Acquired on the Phoenix ICON. Pediatric retinal photograph (wide-field).
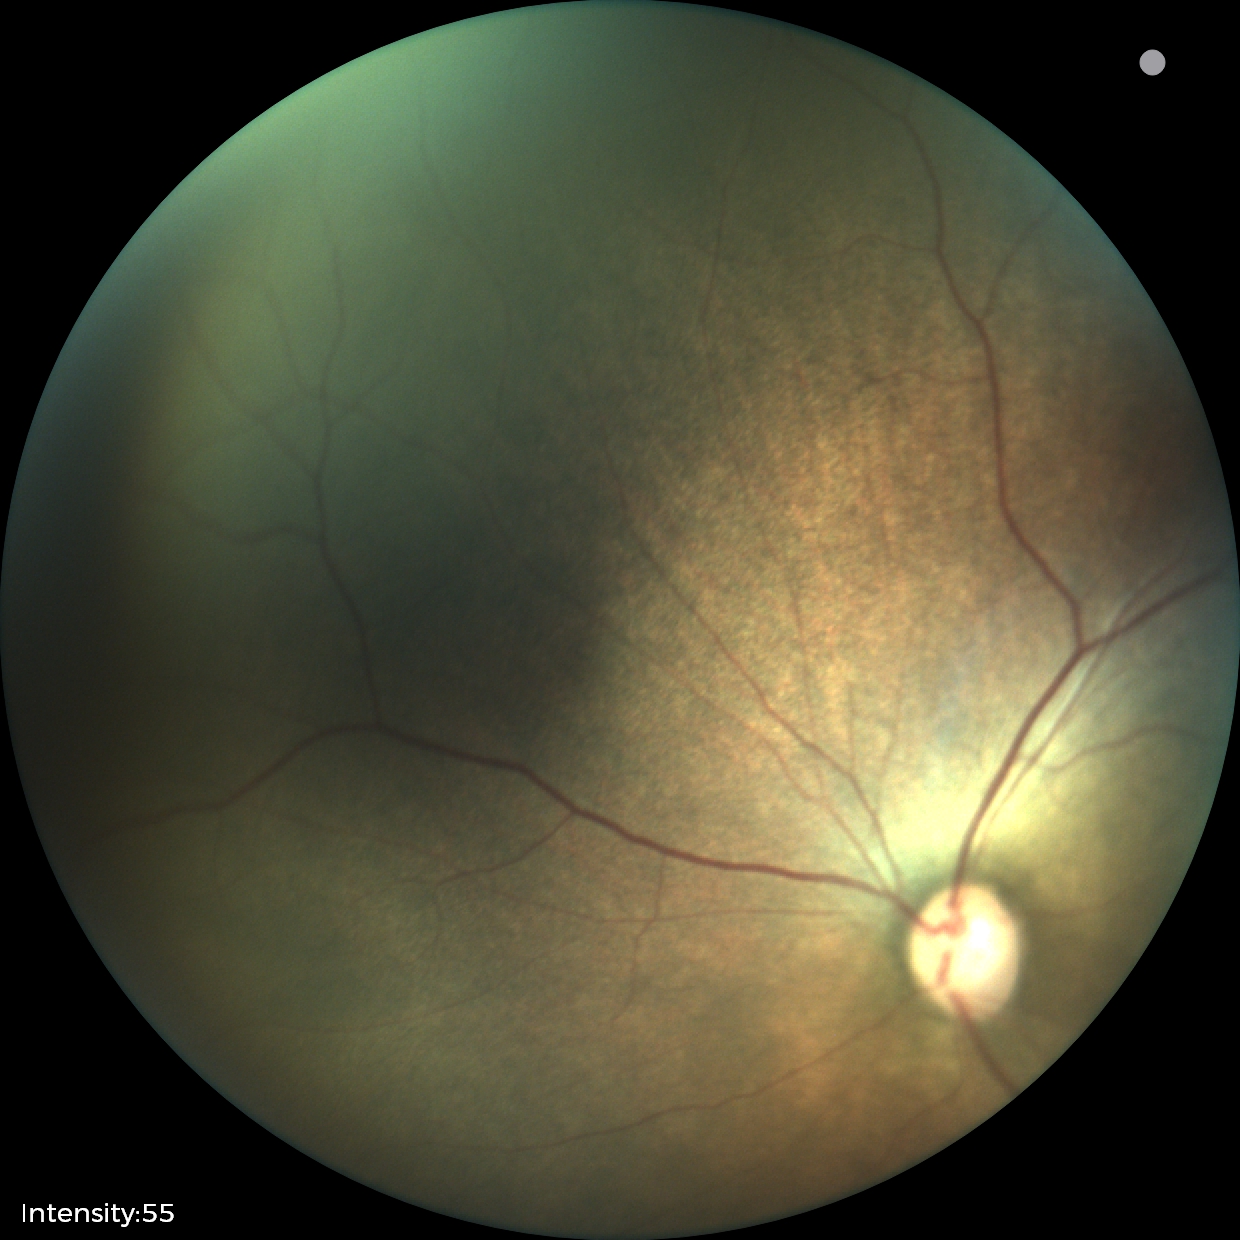

Finding = status post retinopathy of prematurity (ROP).